848x848. Modified Davis grading — 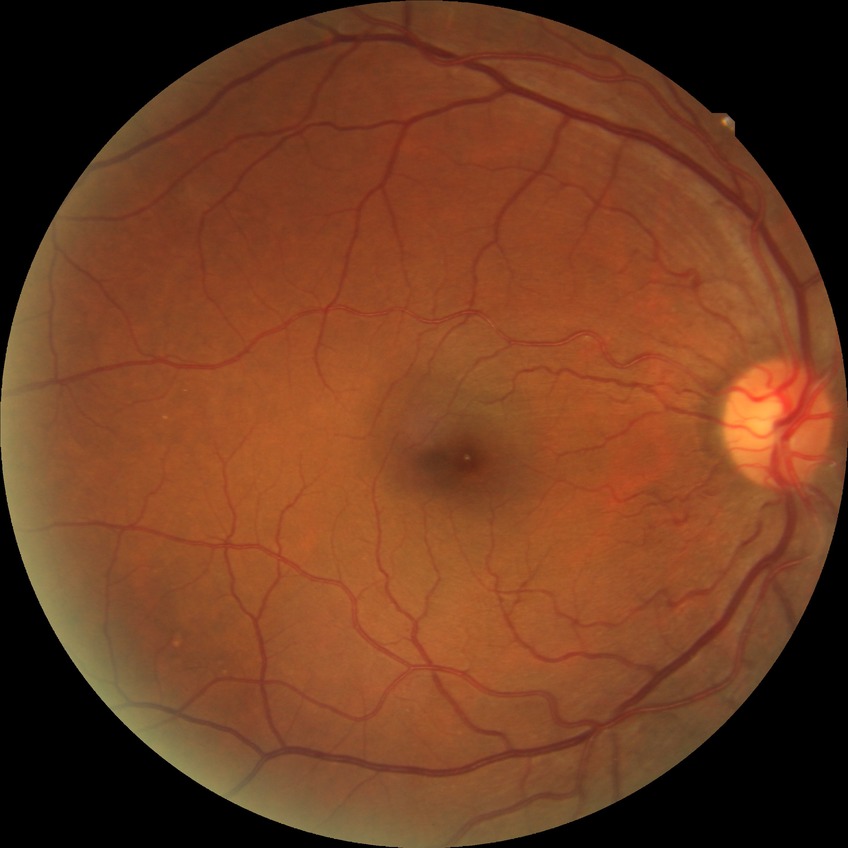
modified Davis grading: no diabetic retinopathy.